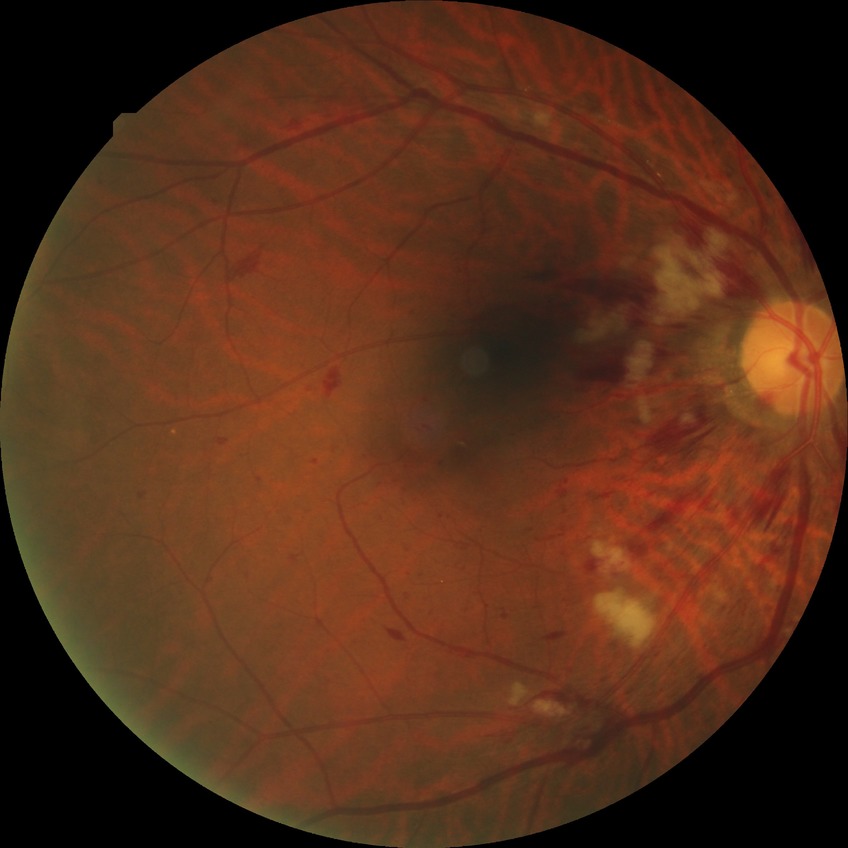

Annotations:
• Davis grade: PPDR